2352x1568px · color fundus photograph · FOV: 45 degrees.
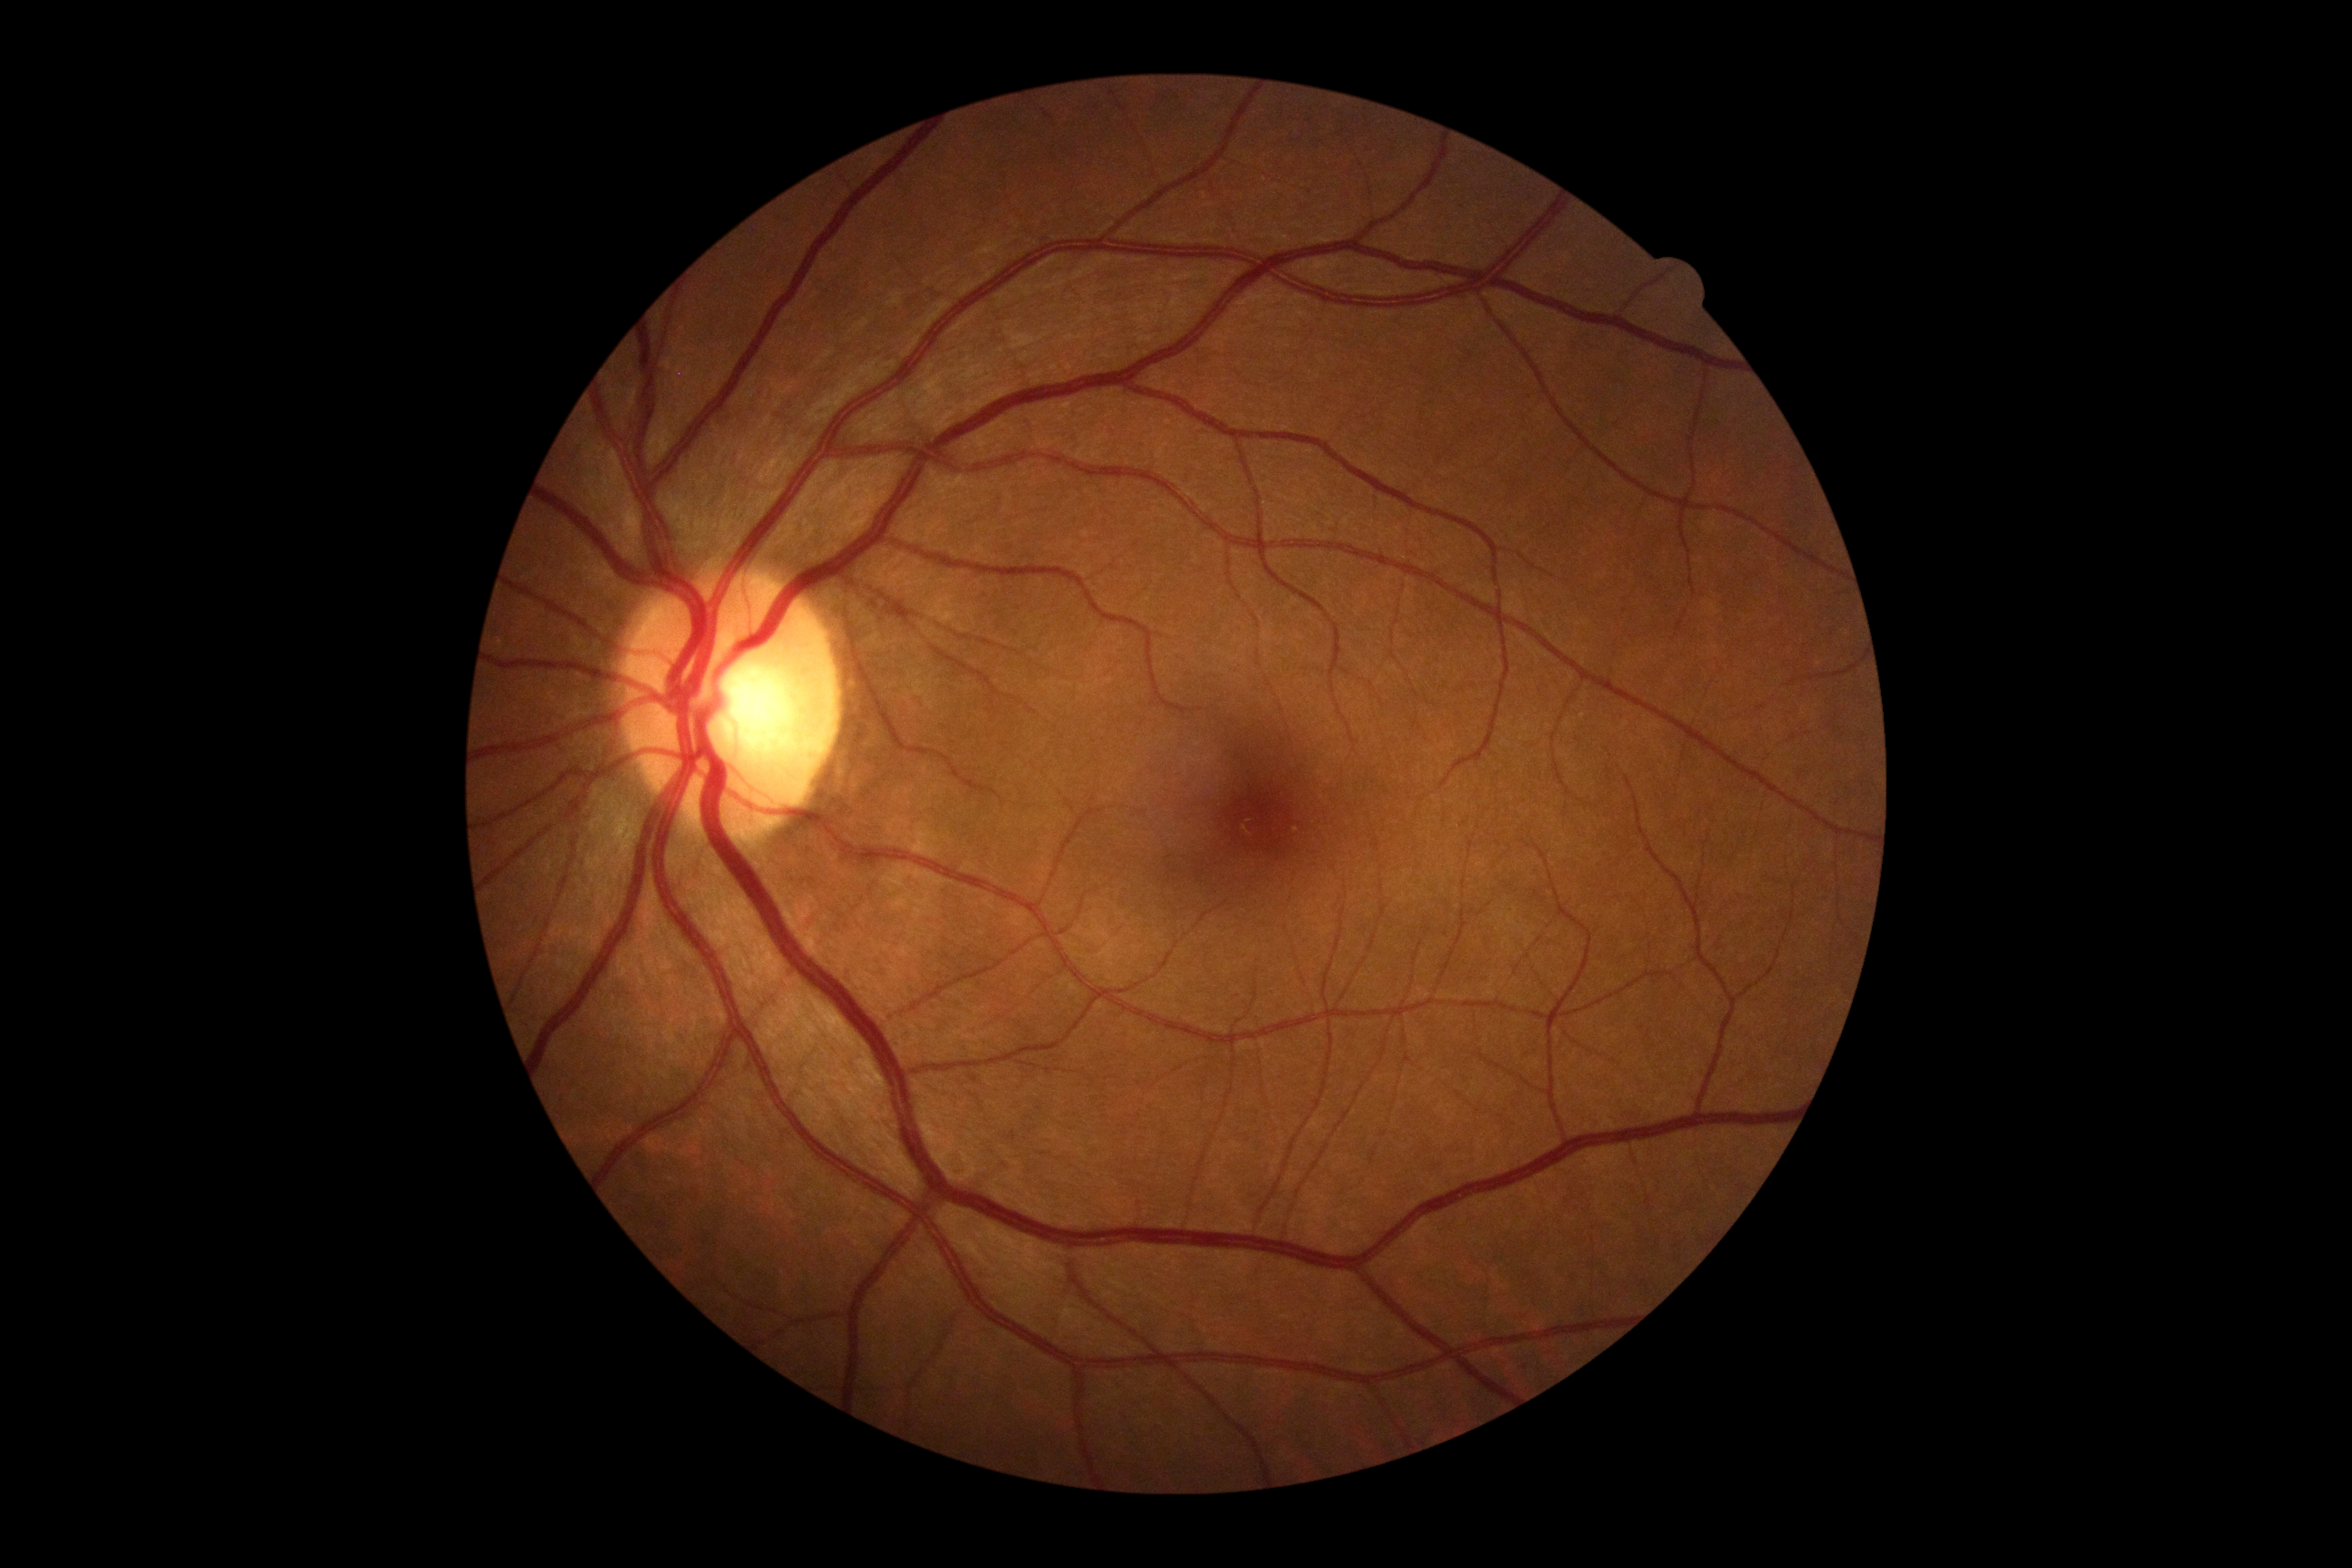 DR grade is 0.
No signs of diabetic retinopathy.